2048x1536px, FOV: 45 degrees, CFP:
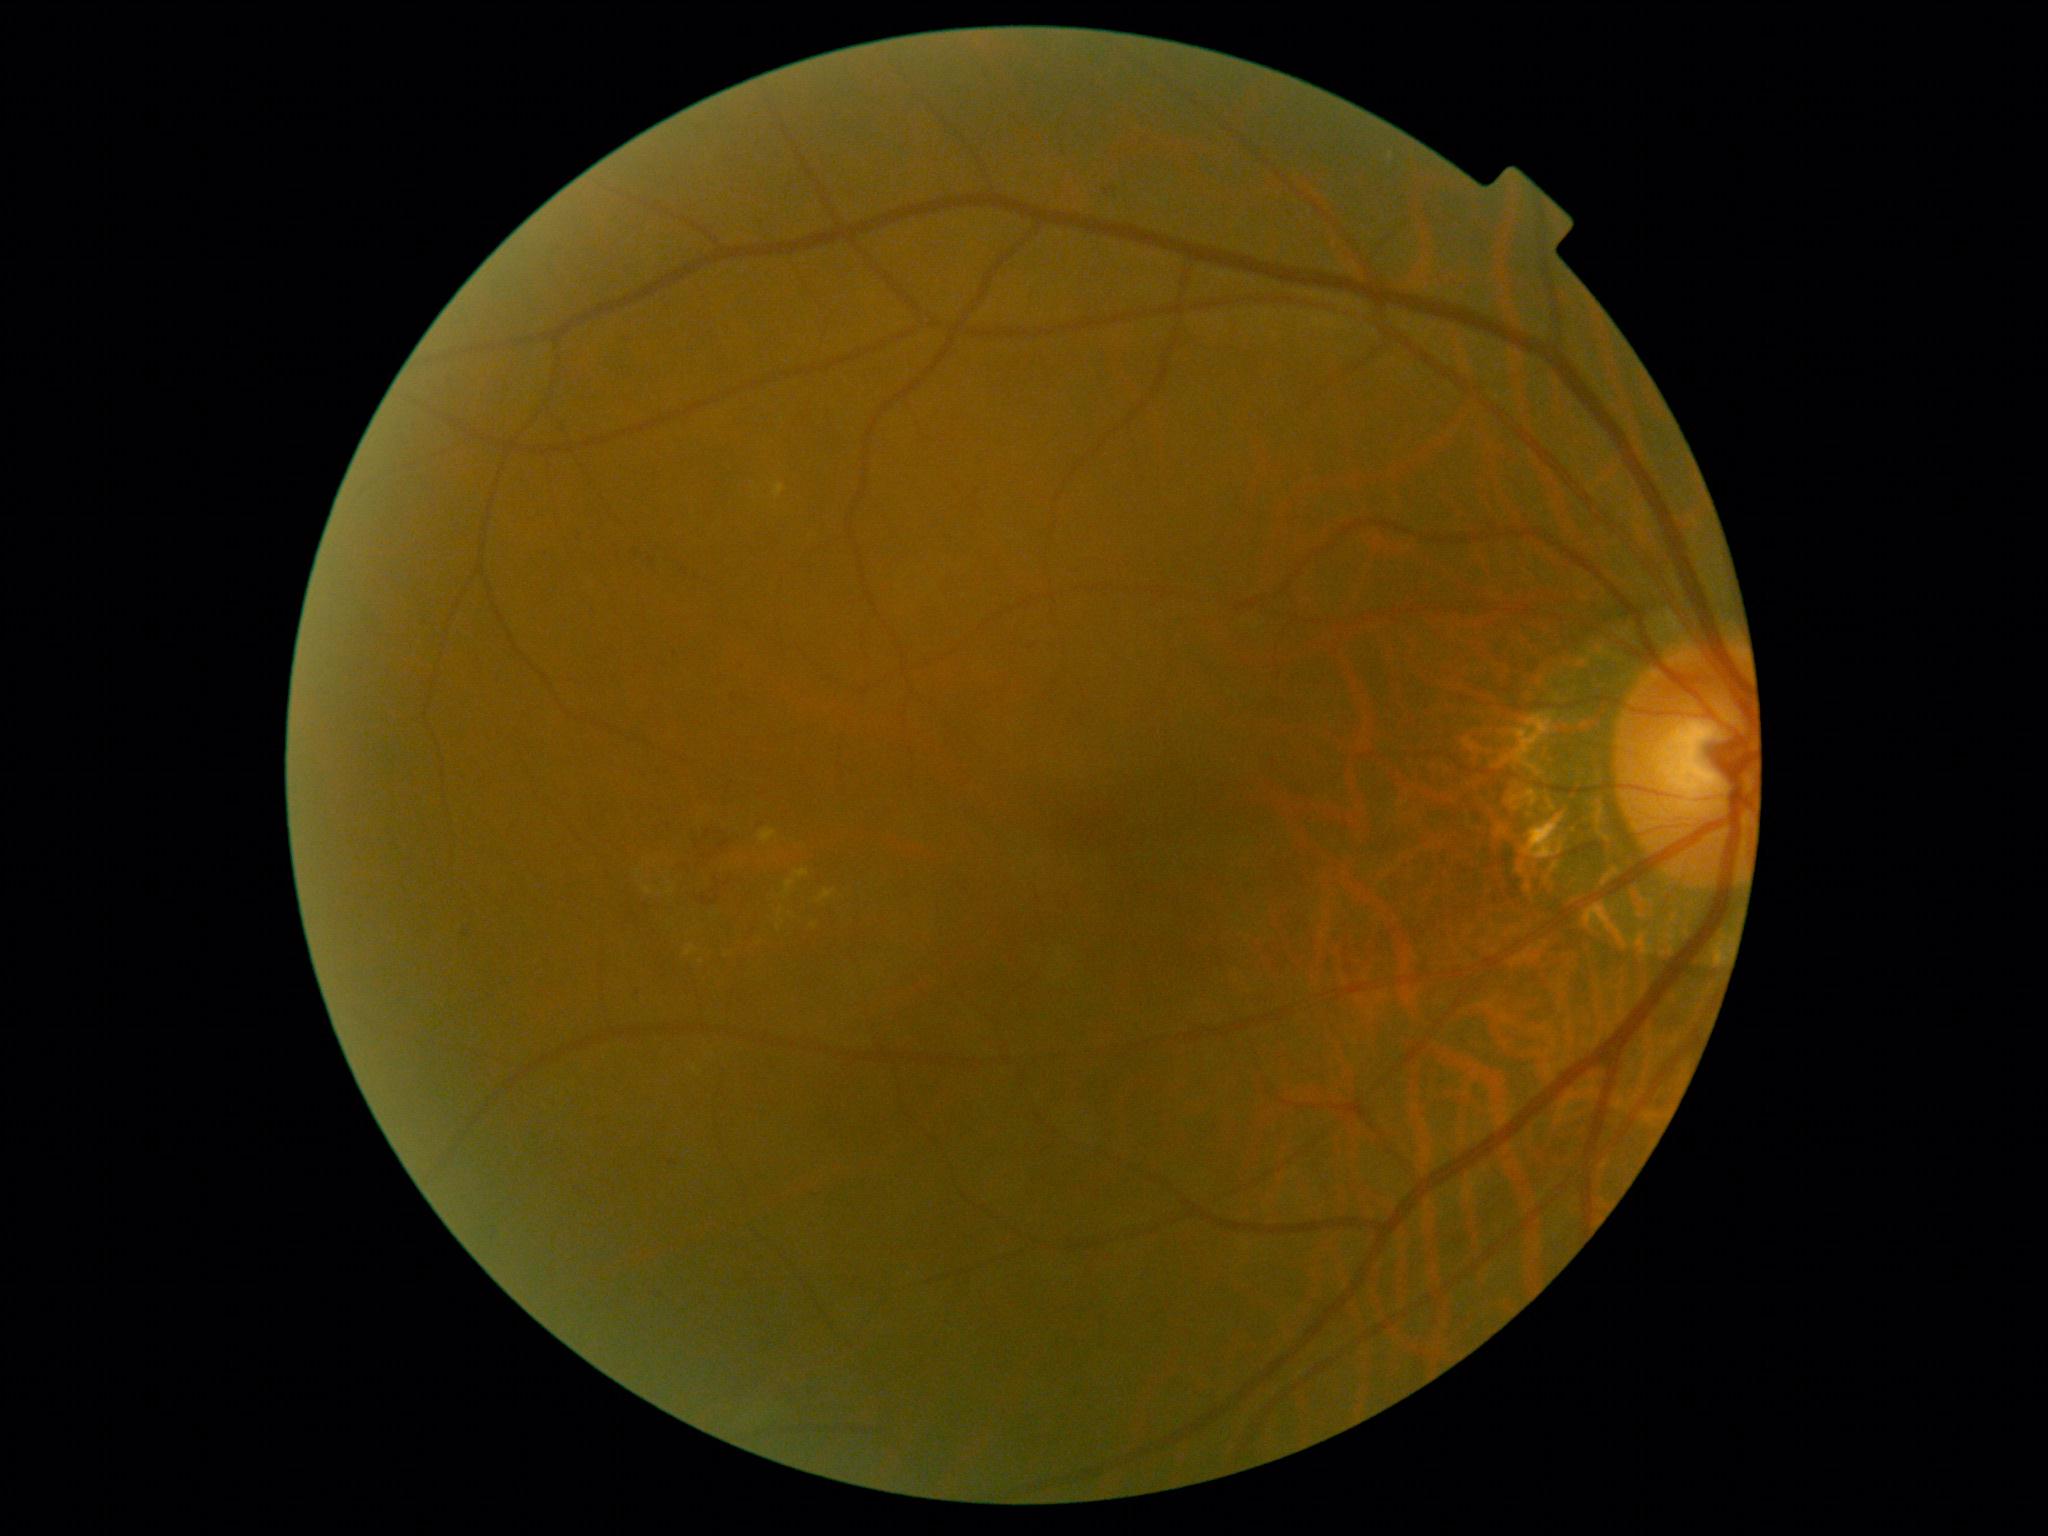
Disease class: non-proliferative diabetic retinopathy.
Diabetic retinopathy grade: moderate NPDR (2).